848 by 848 pixels, no pharmacologic dilation, 45-degree field of view
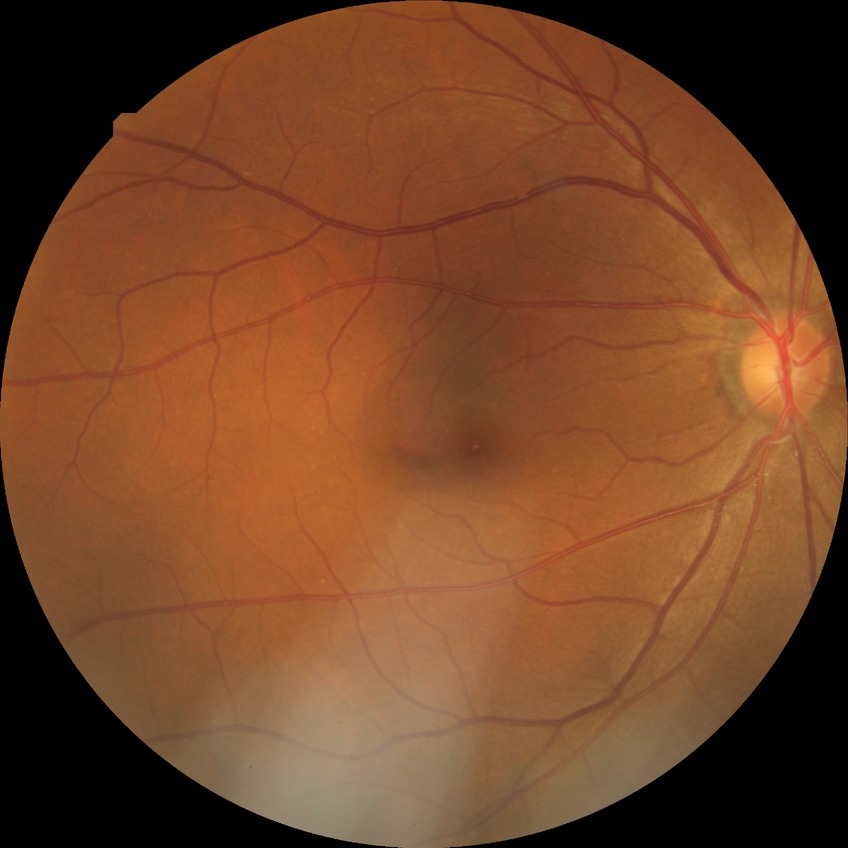
retinopathy grade: no diabetic retinopathy